UWF retinal mosaic: 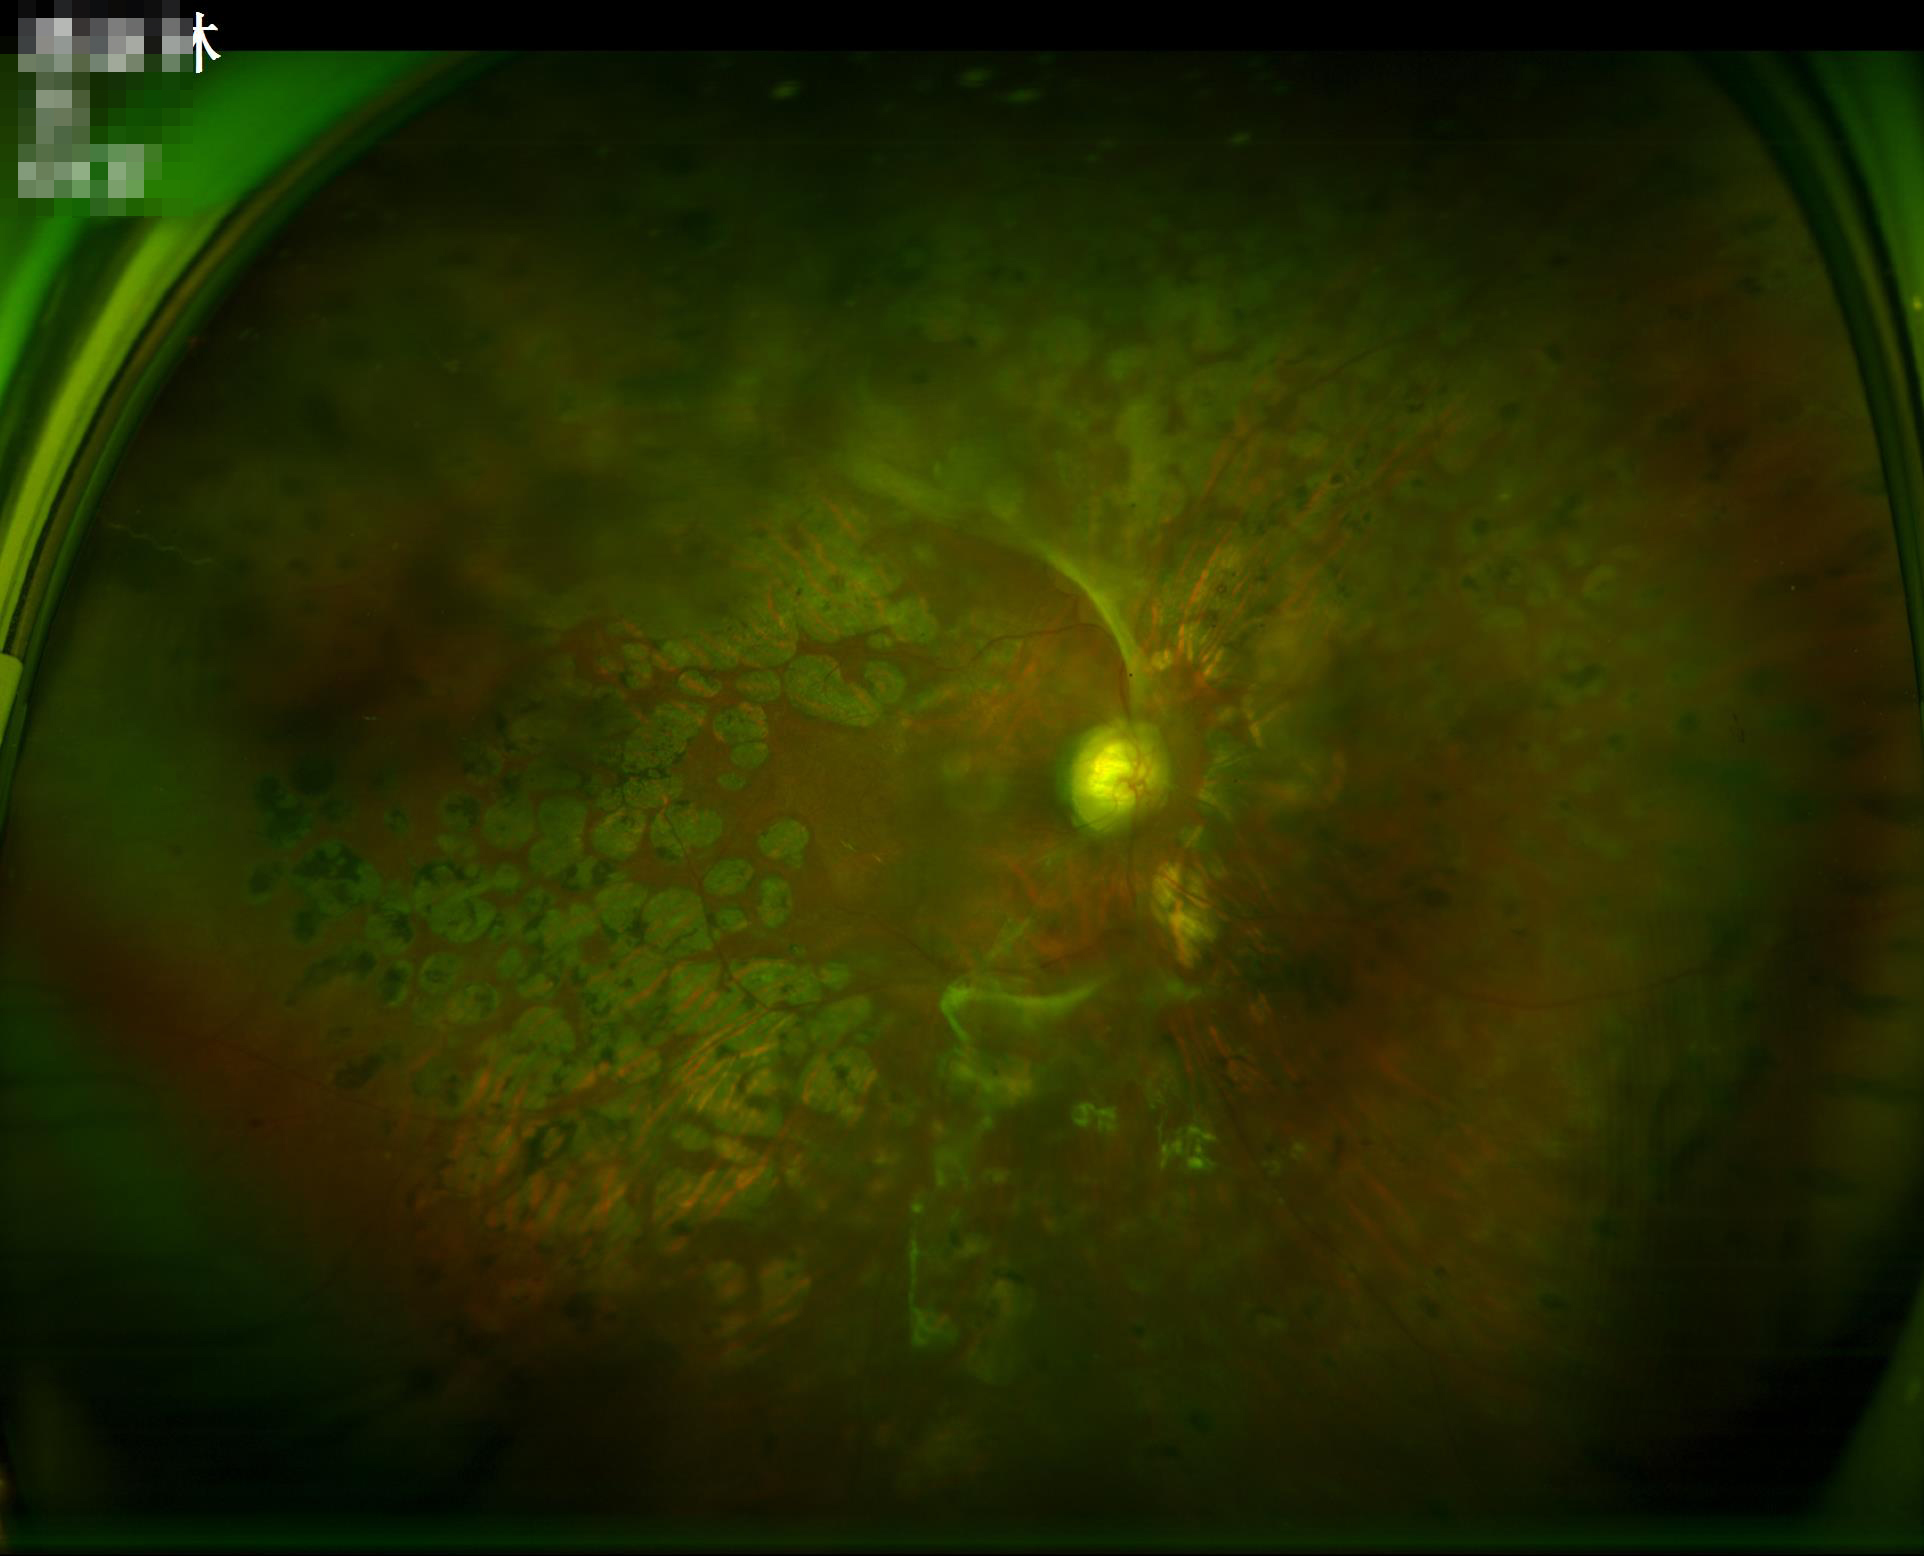

Contrast = low, vessels and details hard to distinguish; Overall quality = inadequate for clinical interpretation; Illumination/color = no over- or under-exposure; Sharpness = noticeable blur in the optic disc, vessels, or background.